848x848px, 45° FOV, NIDEK AFC-230: 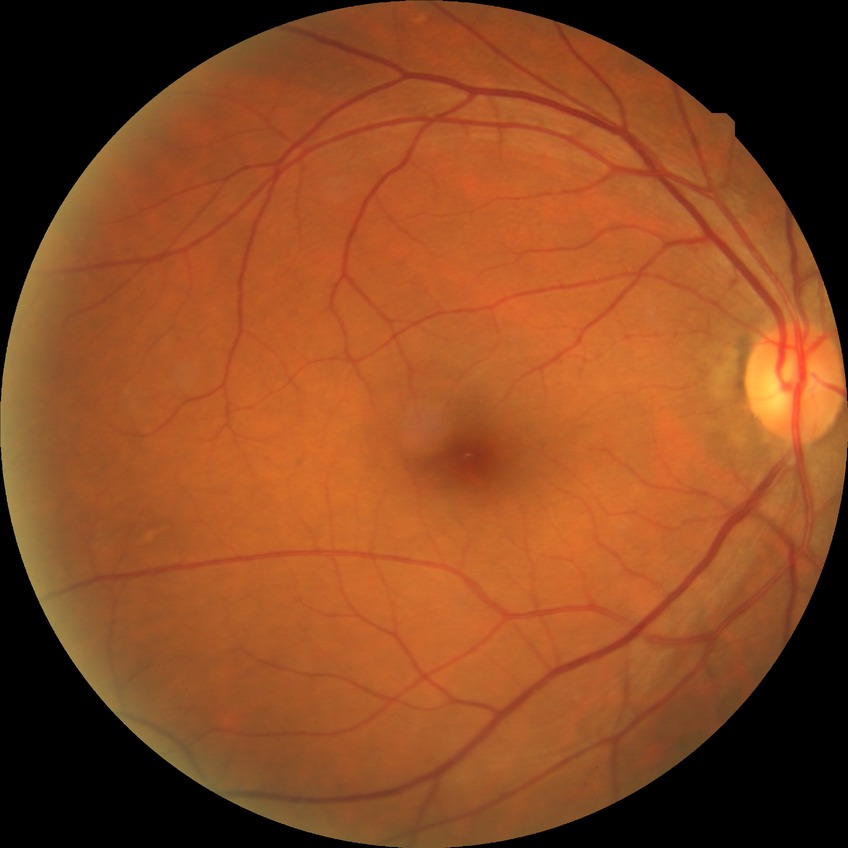 Diabetic retinopathy (DR): NDR (no diabetic retinopathy).